45° FOV · color fundus photograph · image size 1624x1232
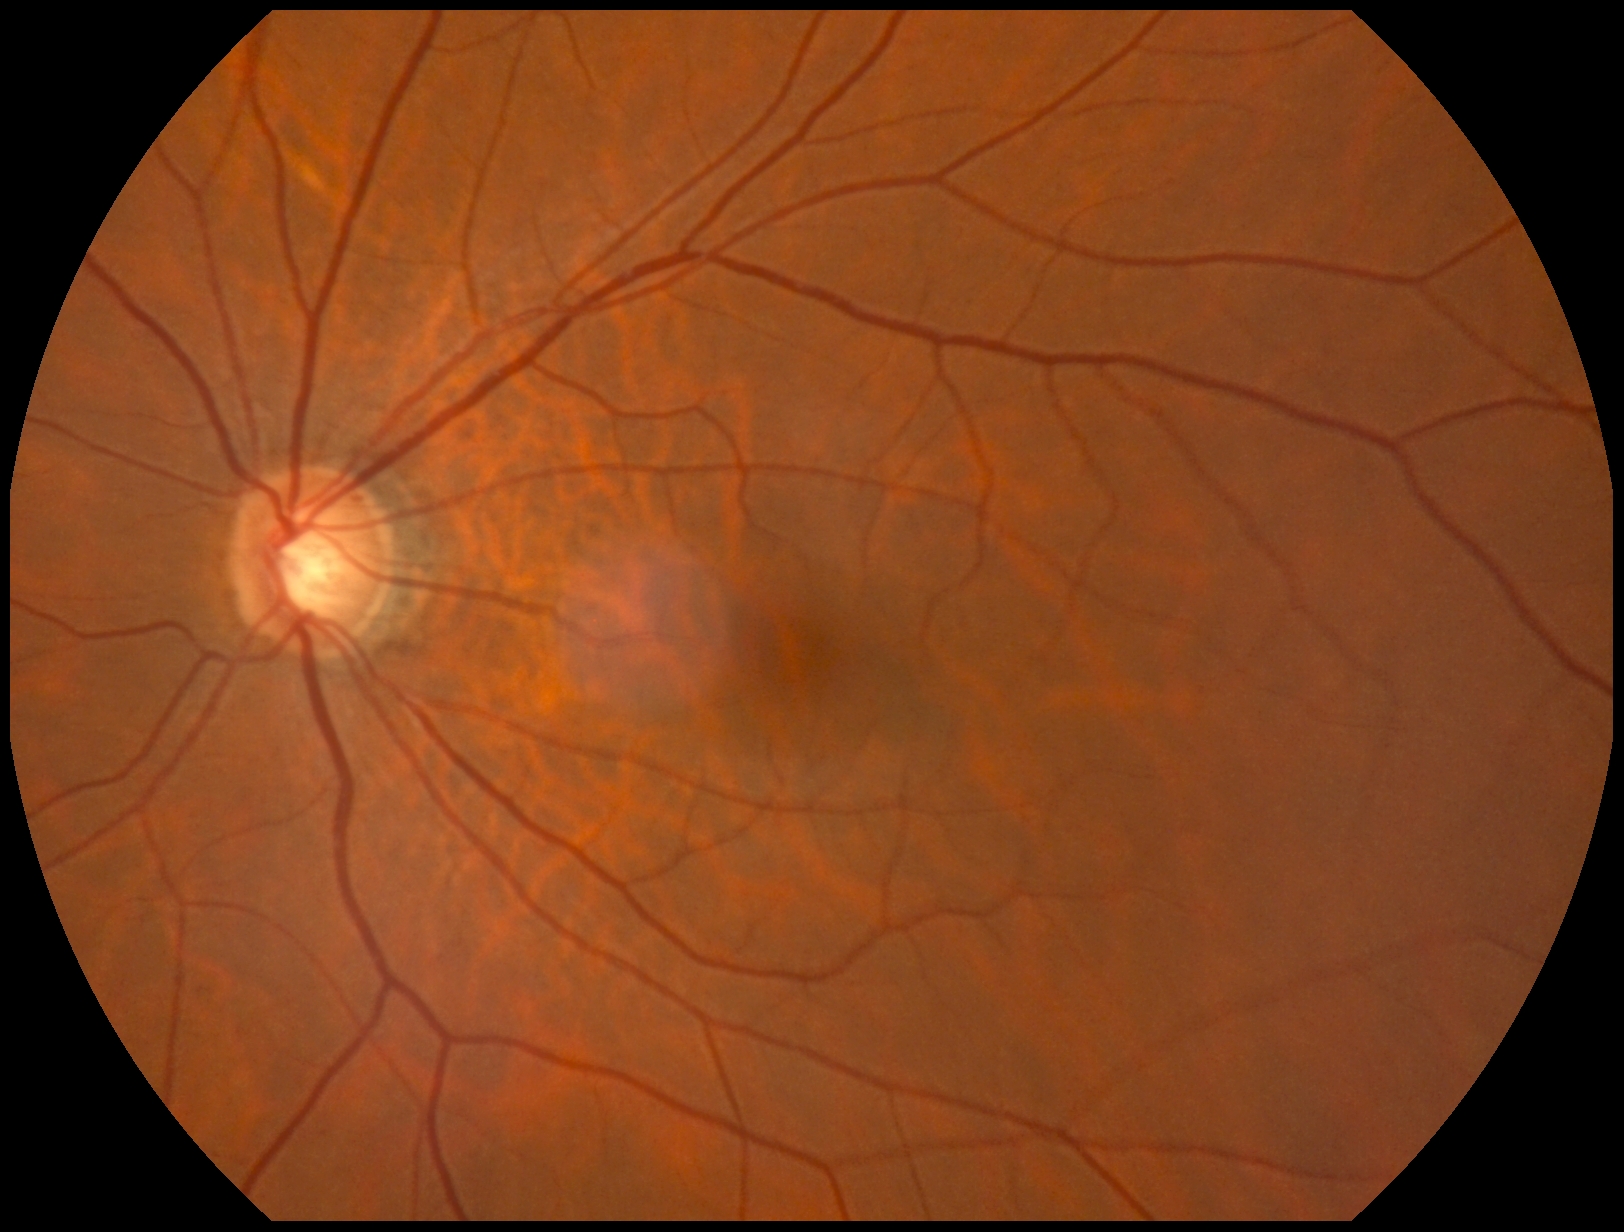
Retinopathy grade: 0 (no apparent retinopathy). No DR findings.